Davis DR grading. NIDEK AFC-230 fundus camera
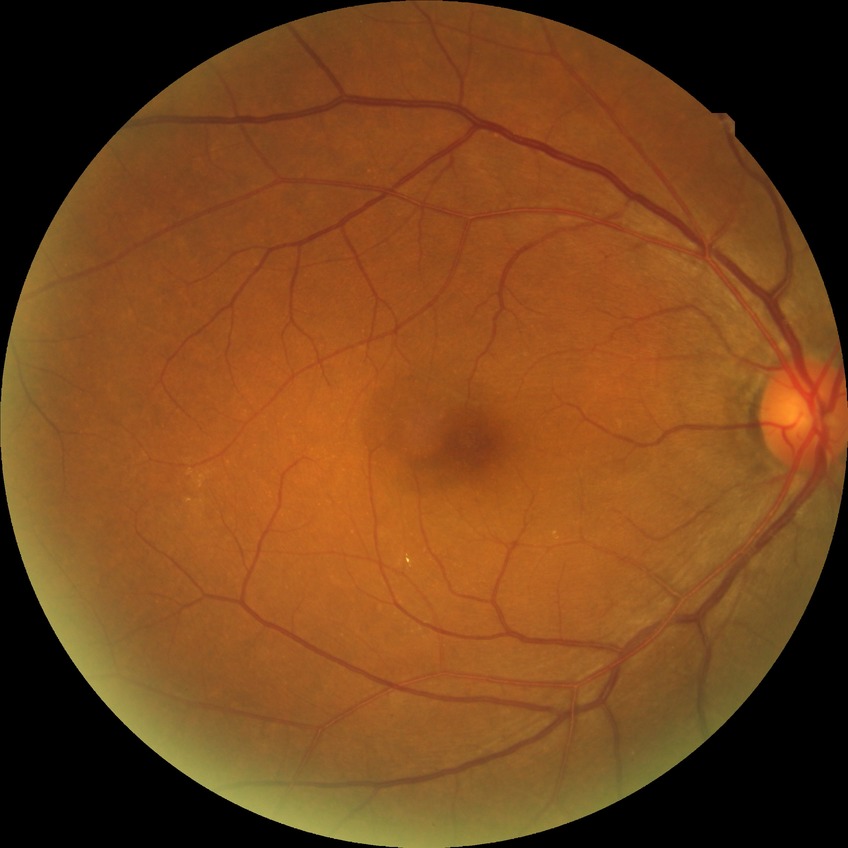
Diabetic retinopathy (DR) is no diabetic retinopathy (NDR).